DR severity per modified Davis staging.
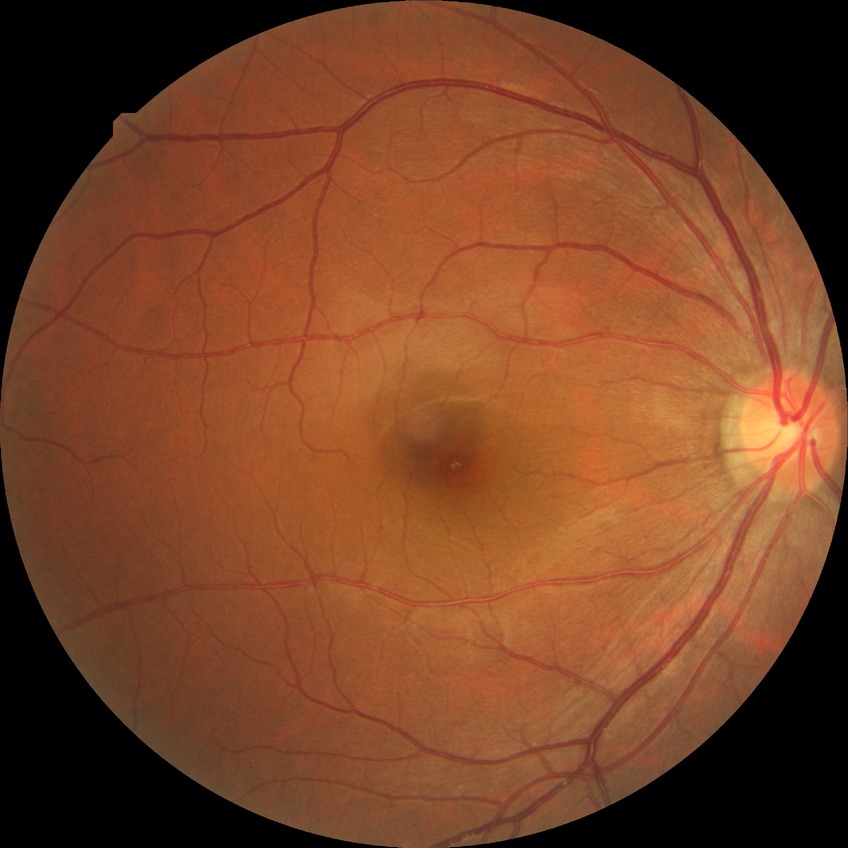
diabetic retinopathy (DR)@NDR (no diabetic retinopathy).